45 degree fundus photograph. NIDEK AFC-230 fundus camera. 848 by 848 pixels. Fundus photo. Without pupil dilation — 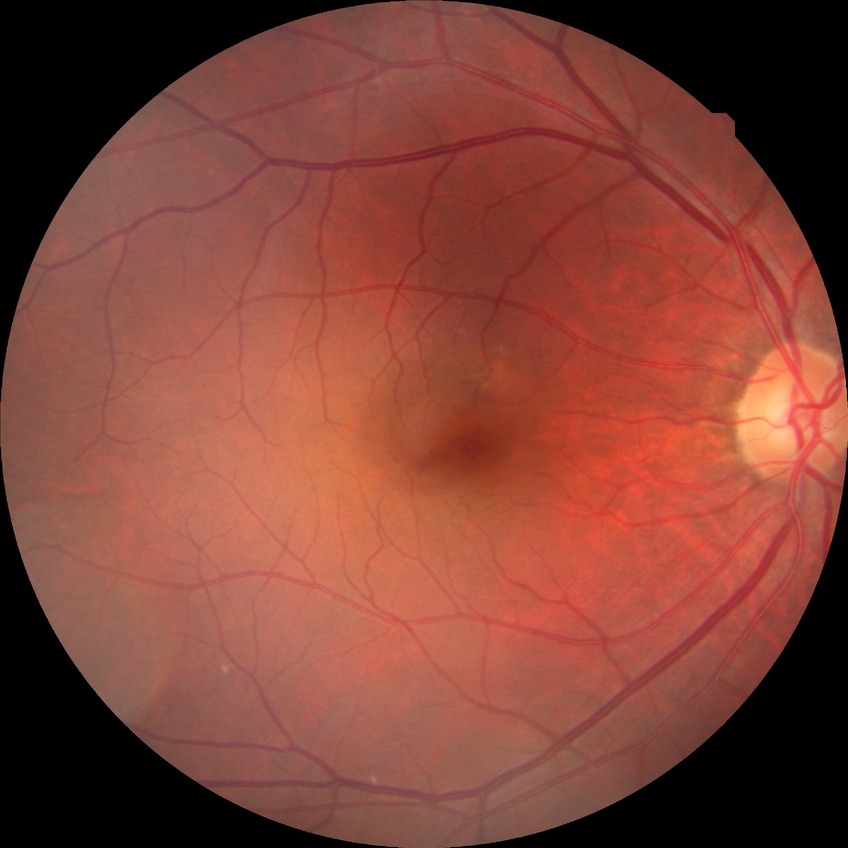

Findings:
* retinopathy grade: no diabetic retinopathy